Image size 640x480; wide-field contact fundus photograph of an infant; Clarity RetCam 3, 130° FOV.
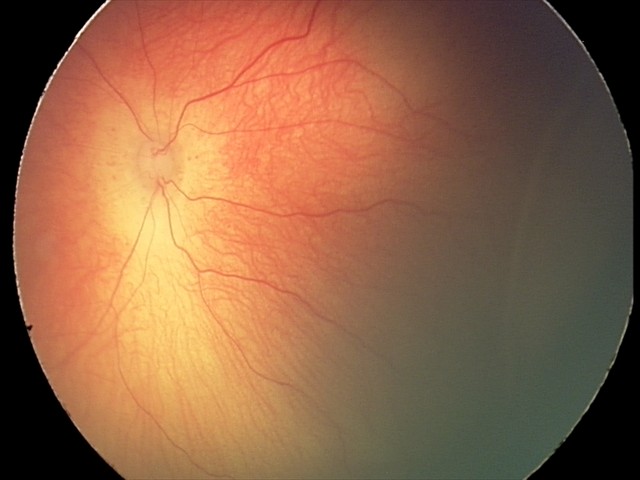 Diagnosis from this screening exam: retinopathy of prematurity stage 2.